Modified Davis classification, NIDEK AFC-230, without pupil dilation: 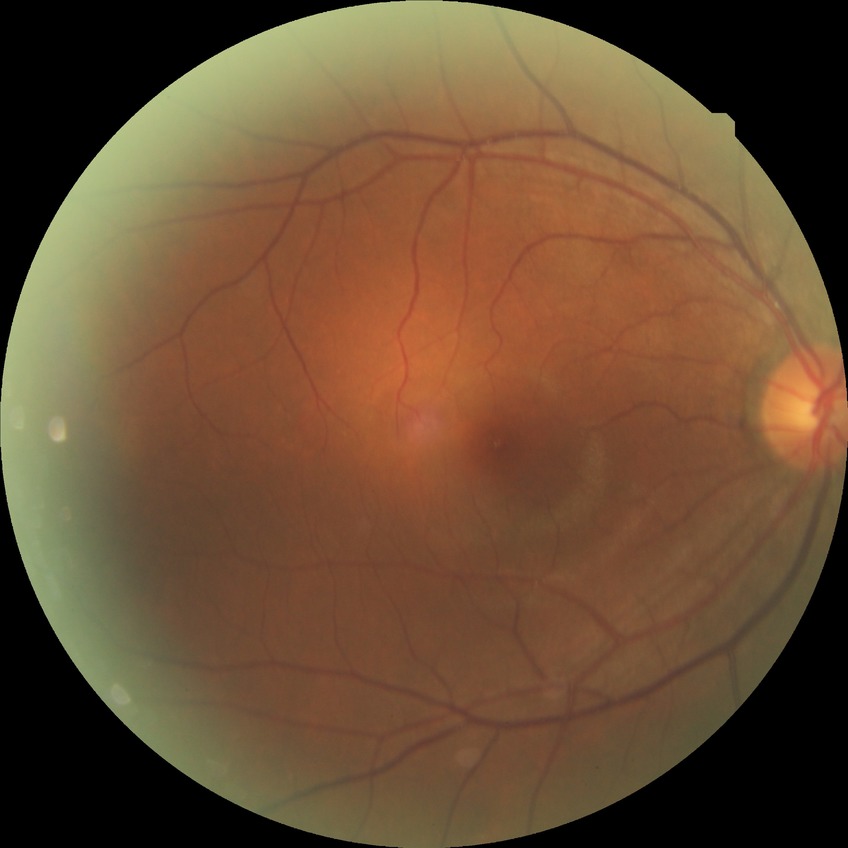 davis_grade: no diabetic retinopathy